2352x1568px; FOV: 45 degrees; CFP: 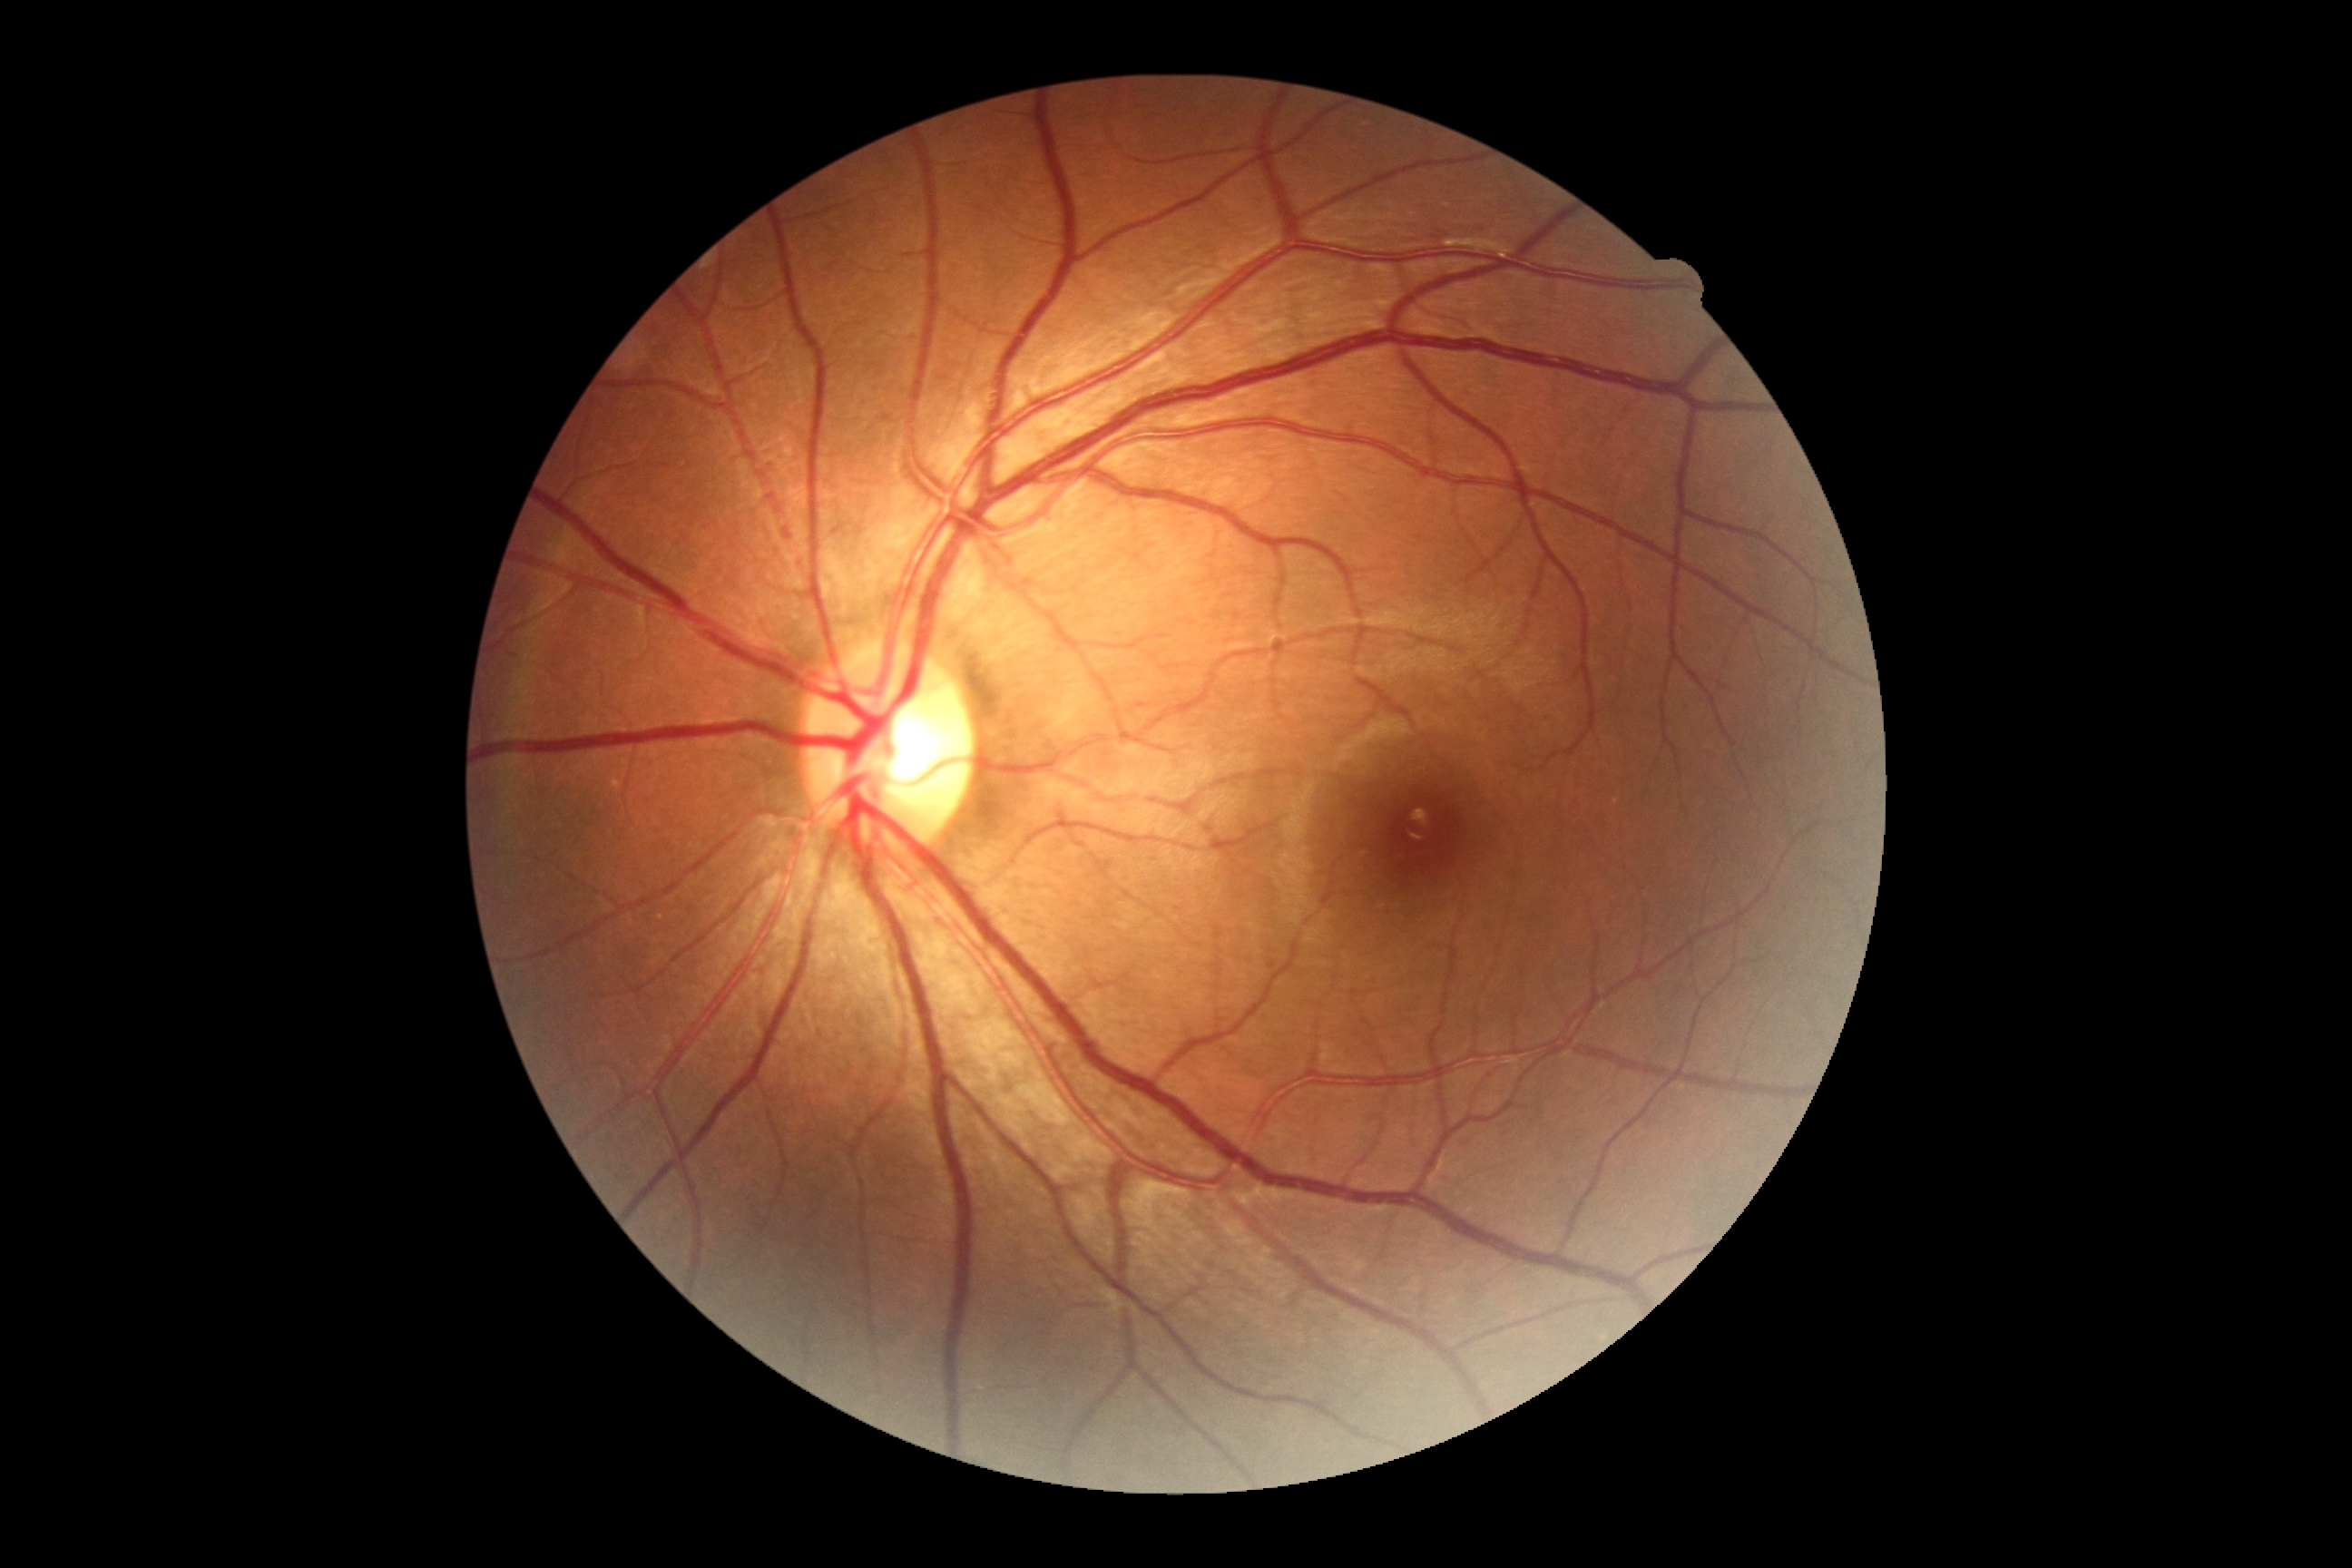 Diabetic retinopathy grade: 0 (no apparent retinopathy).